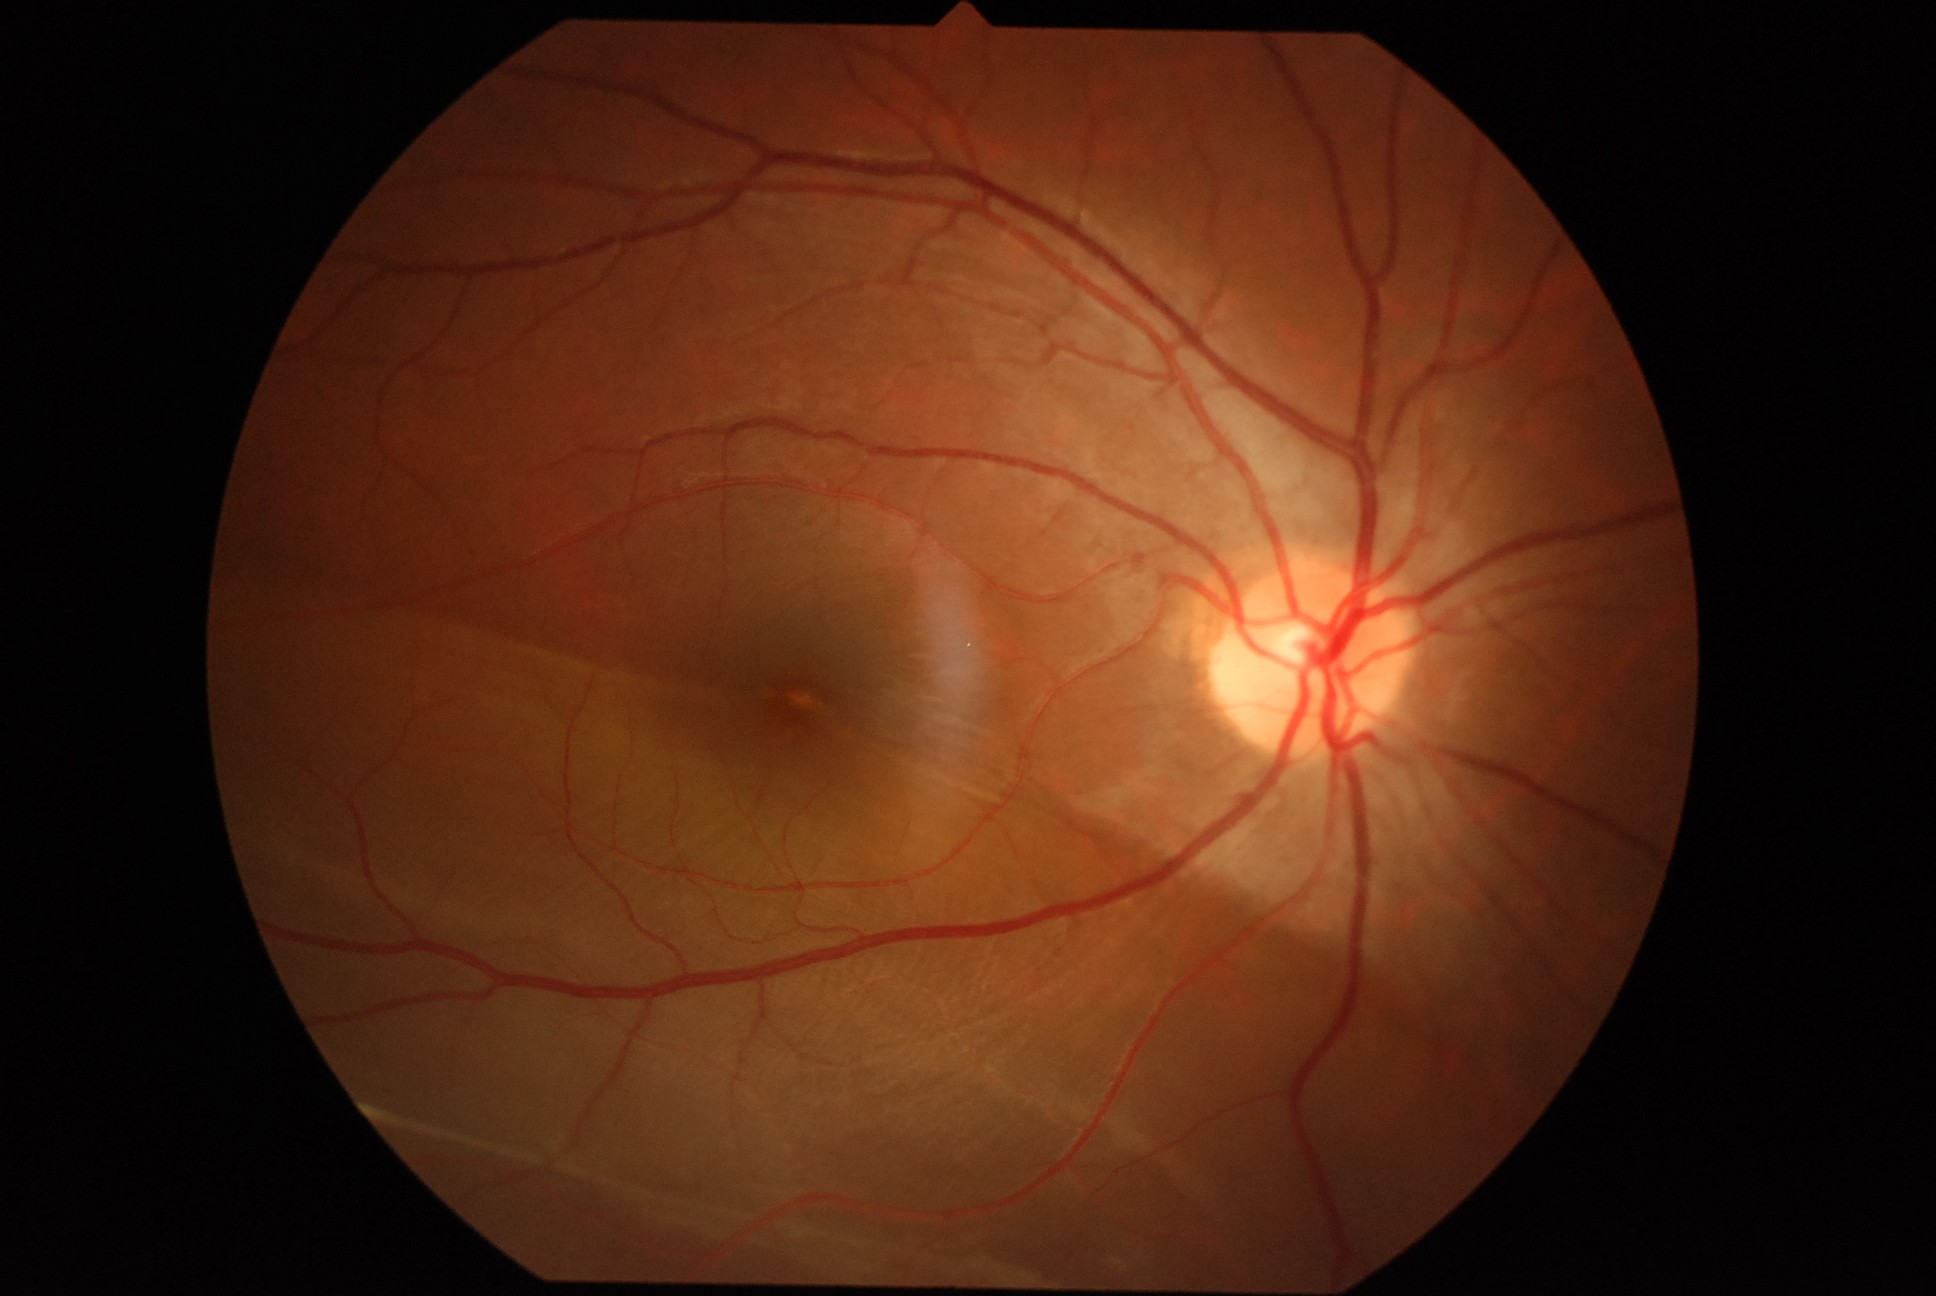 {"dr_category": "proliferative diabetic retinopathy", "dr_grade": "4 (PDR)"}